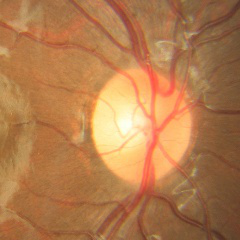 Optic disc appearance consistent with no glaucoma.